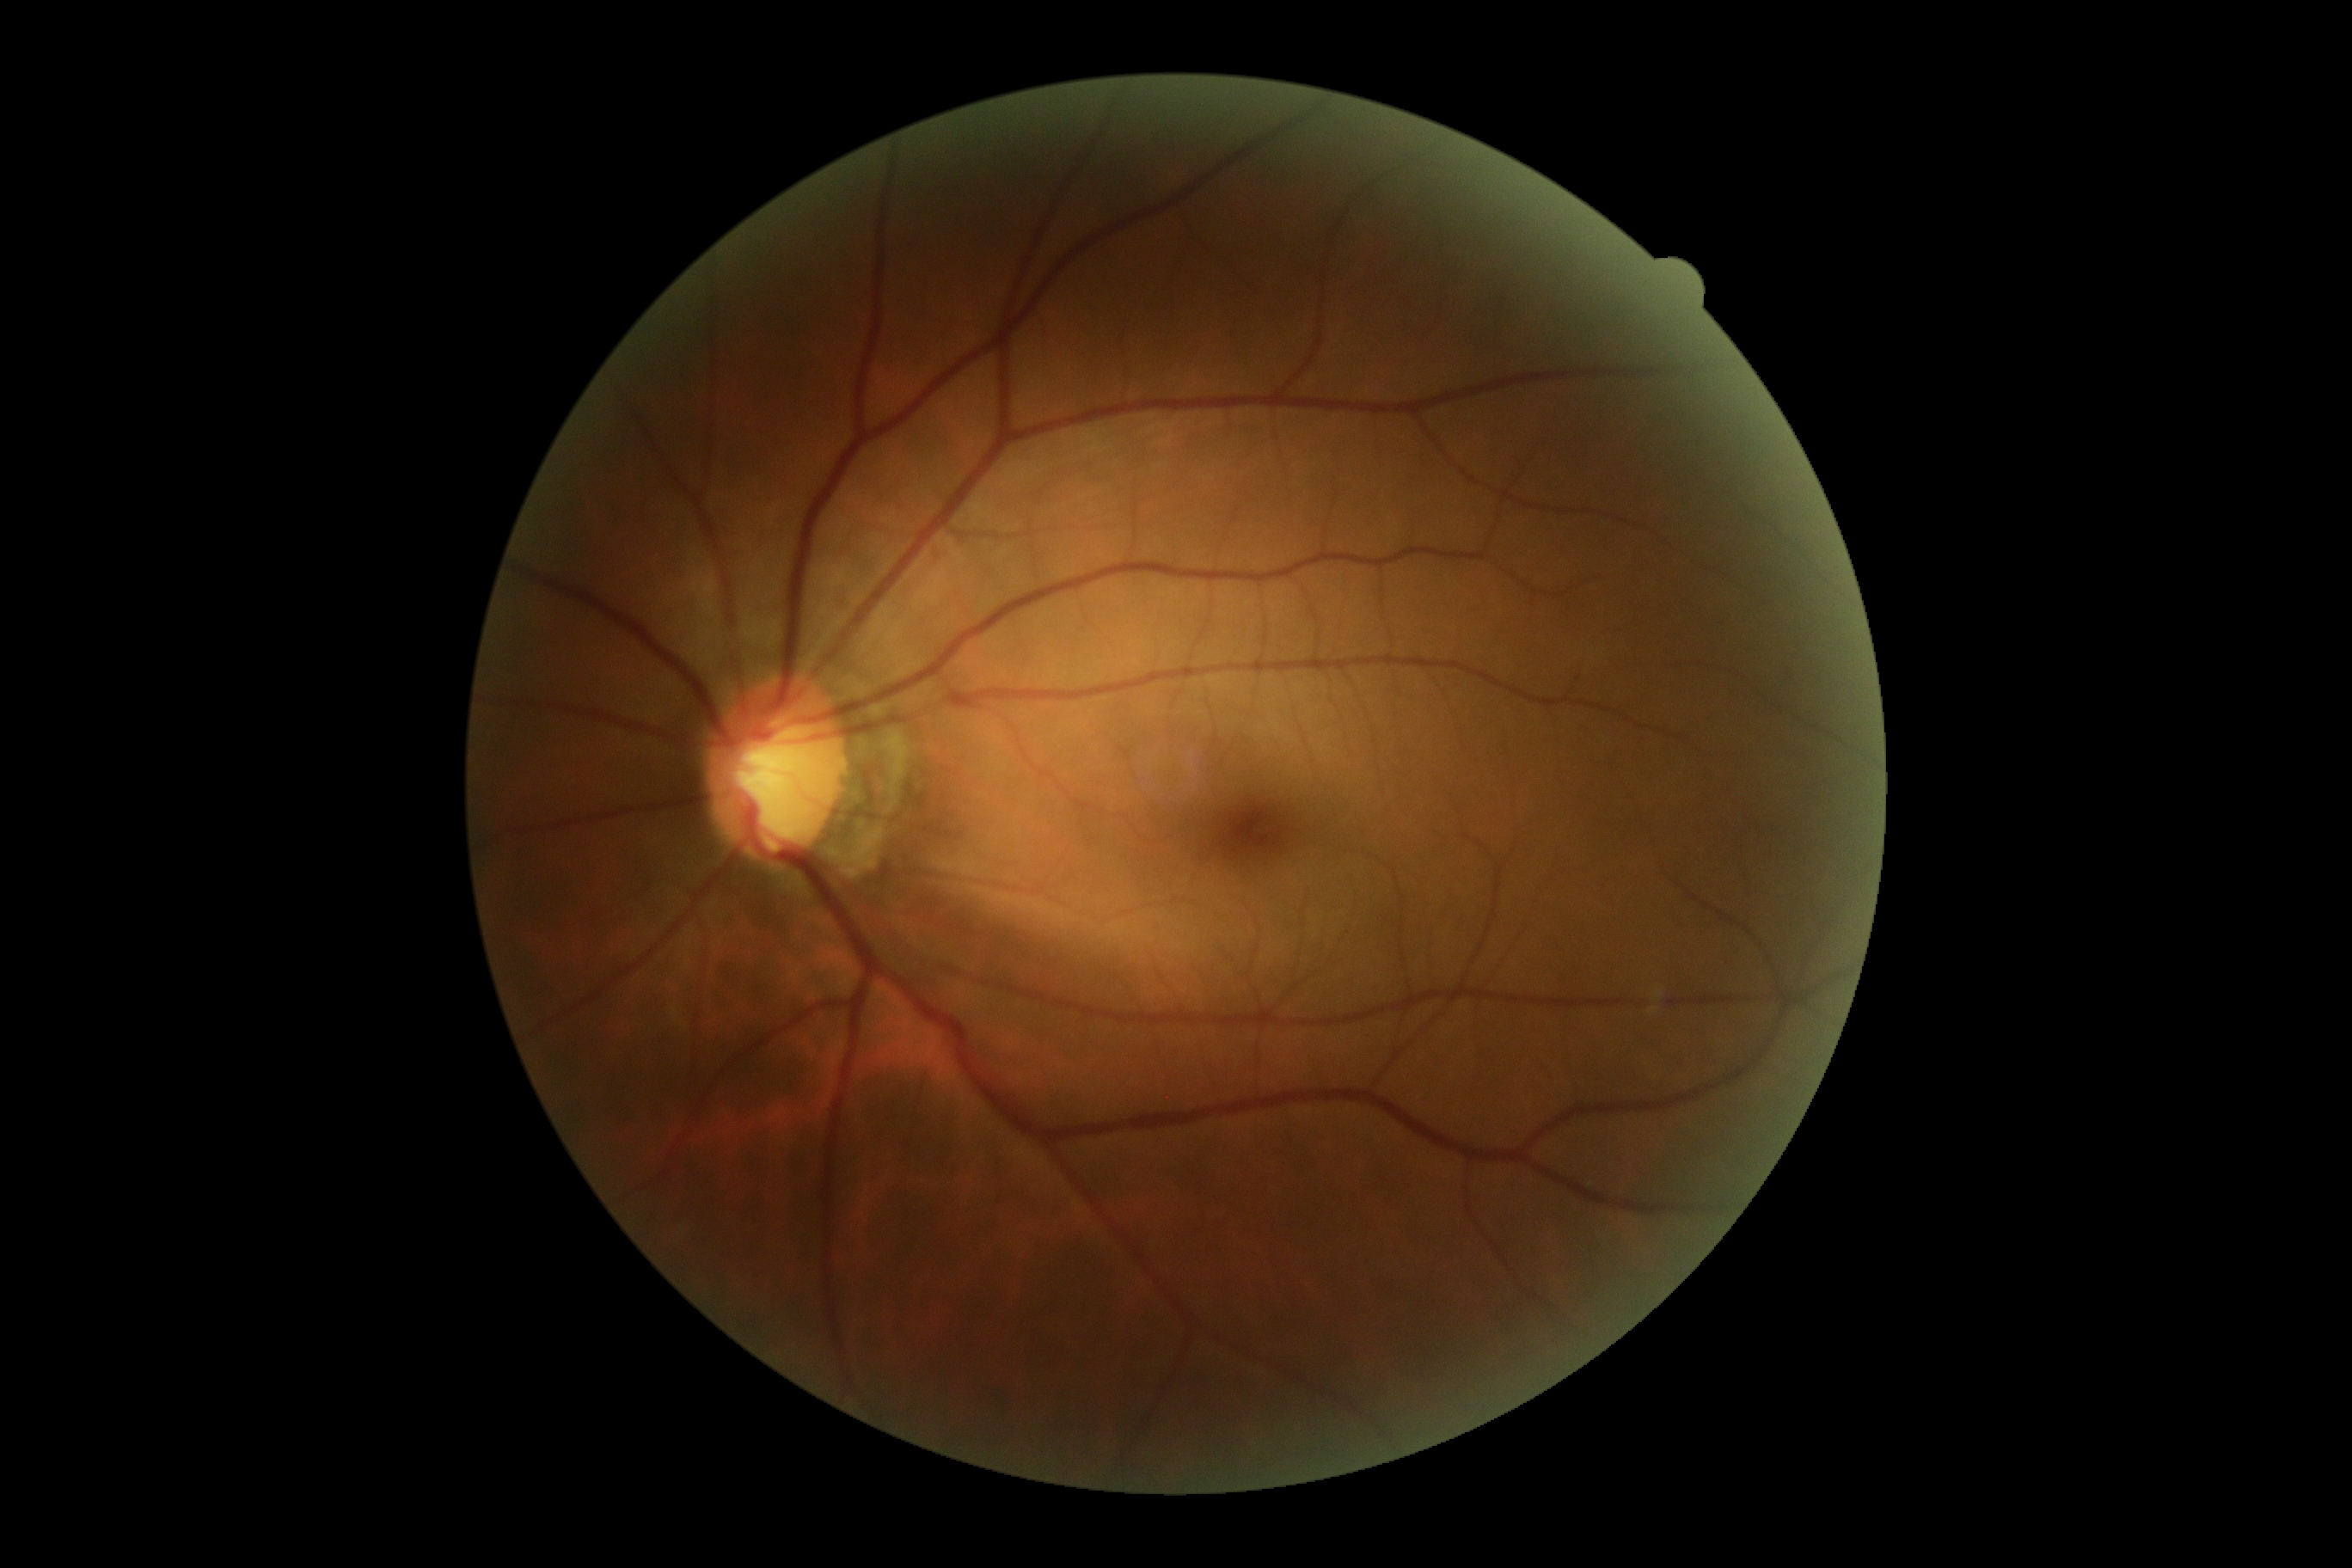
DR: grade 0 (no apparent retinopathy).